1240x1240px · wide-field fundus photograph of an infant · captured with the Phoenix ICON (100° field of view):
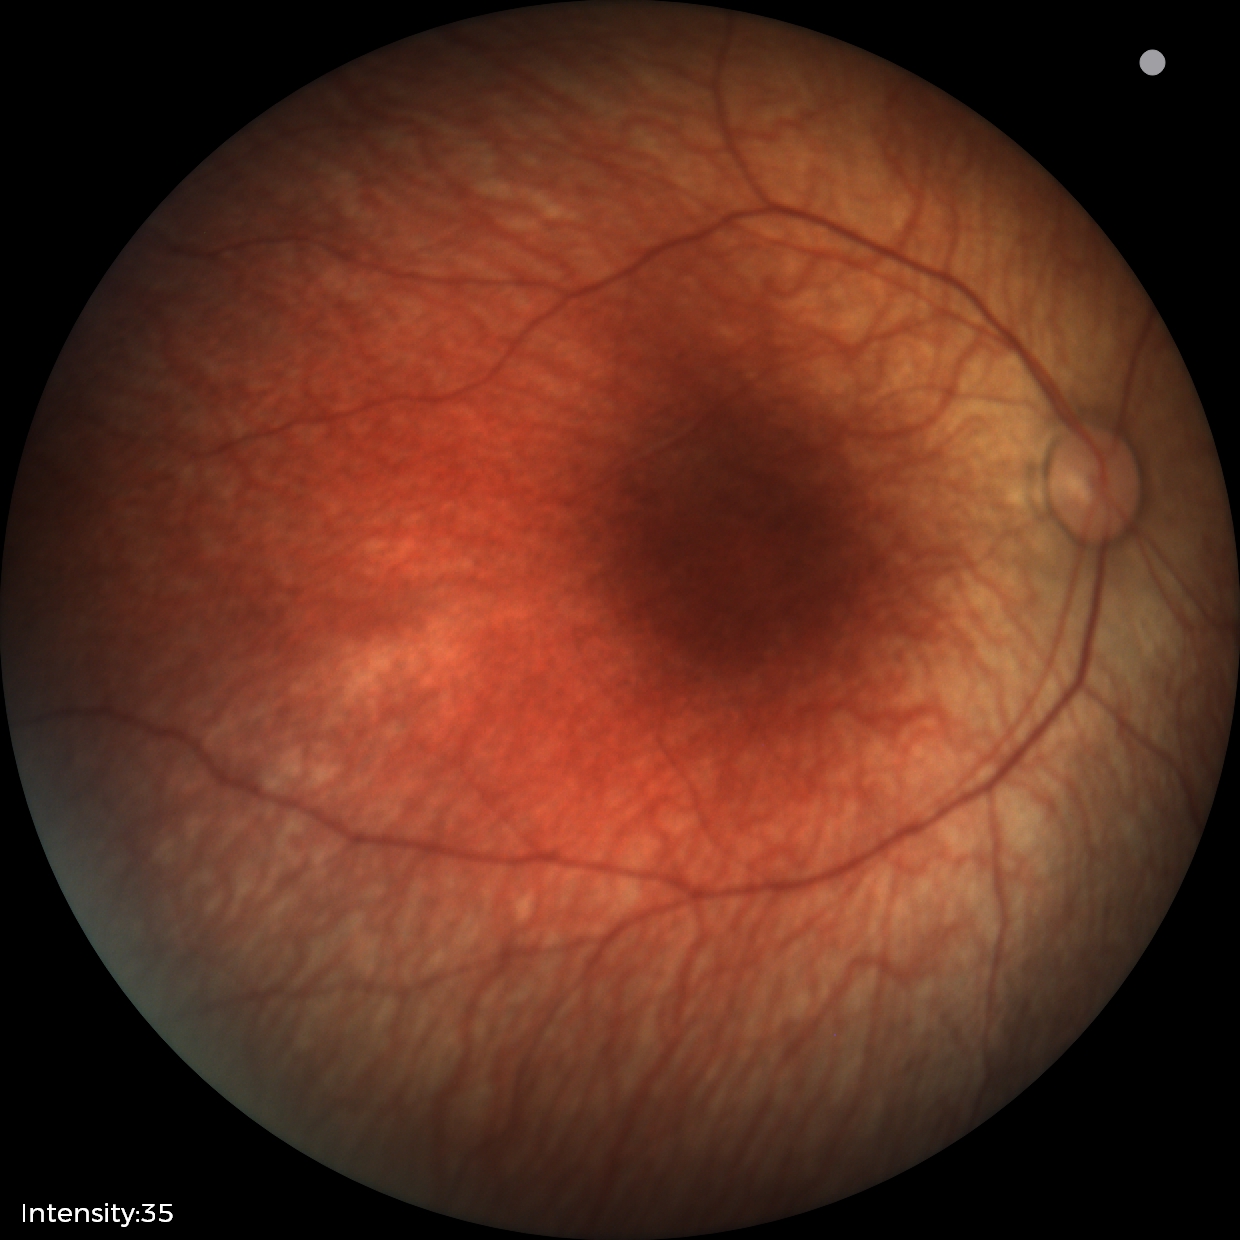 Physiological retinal appearance for postconceptual age.